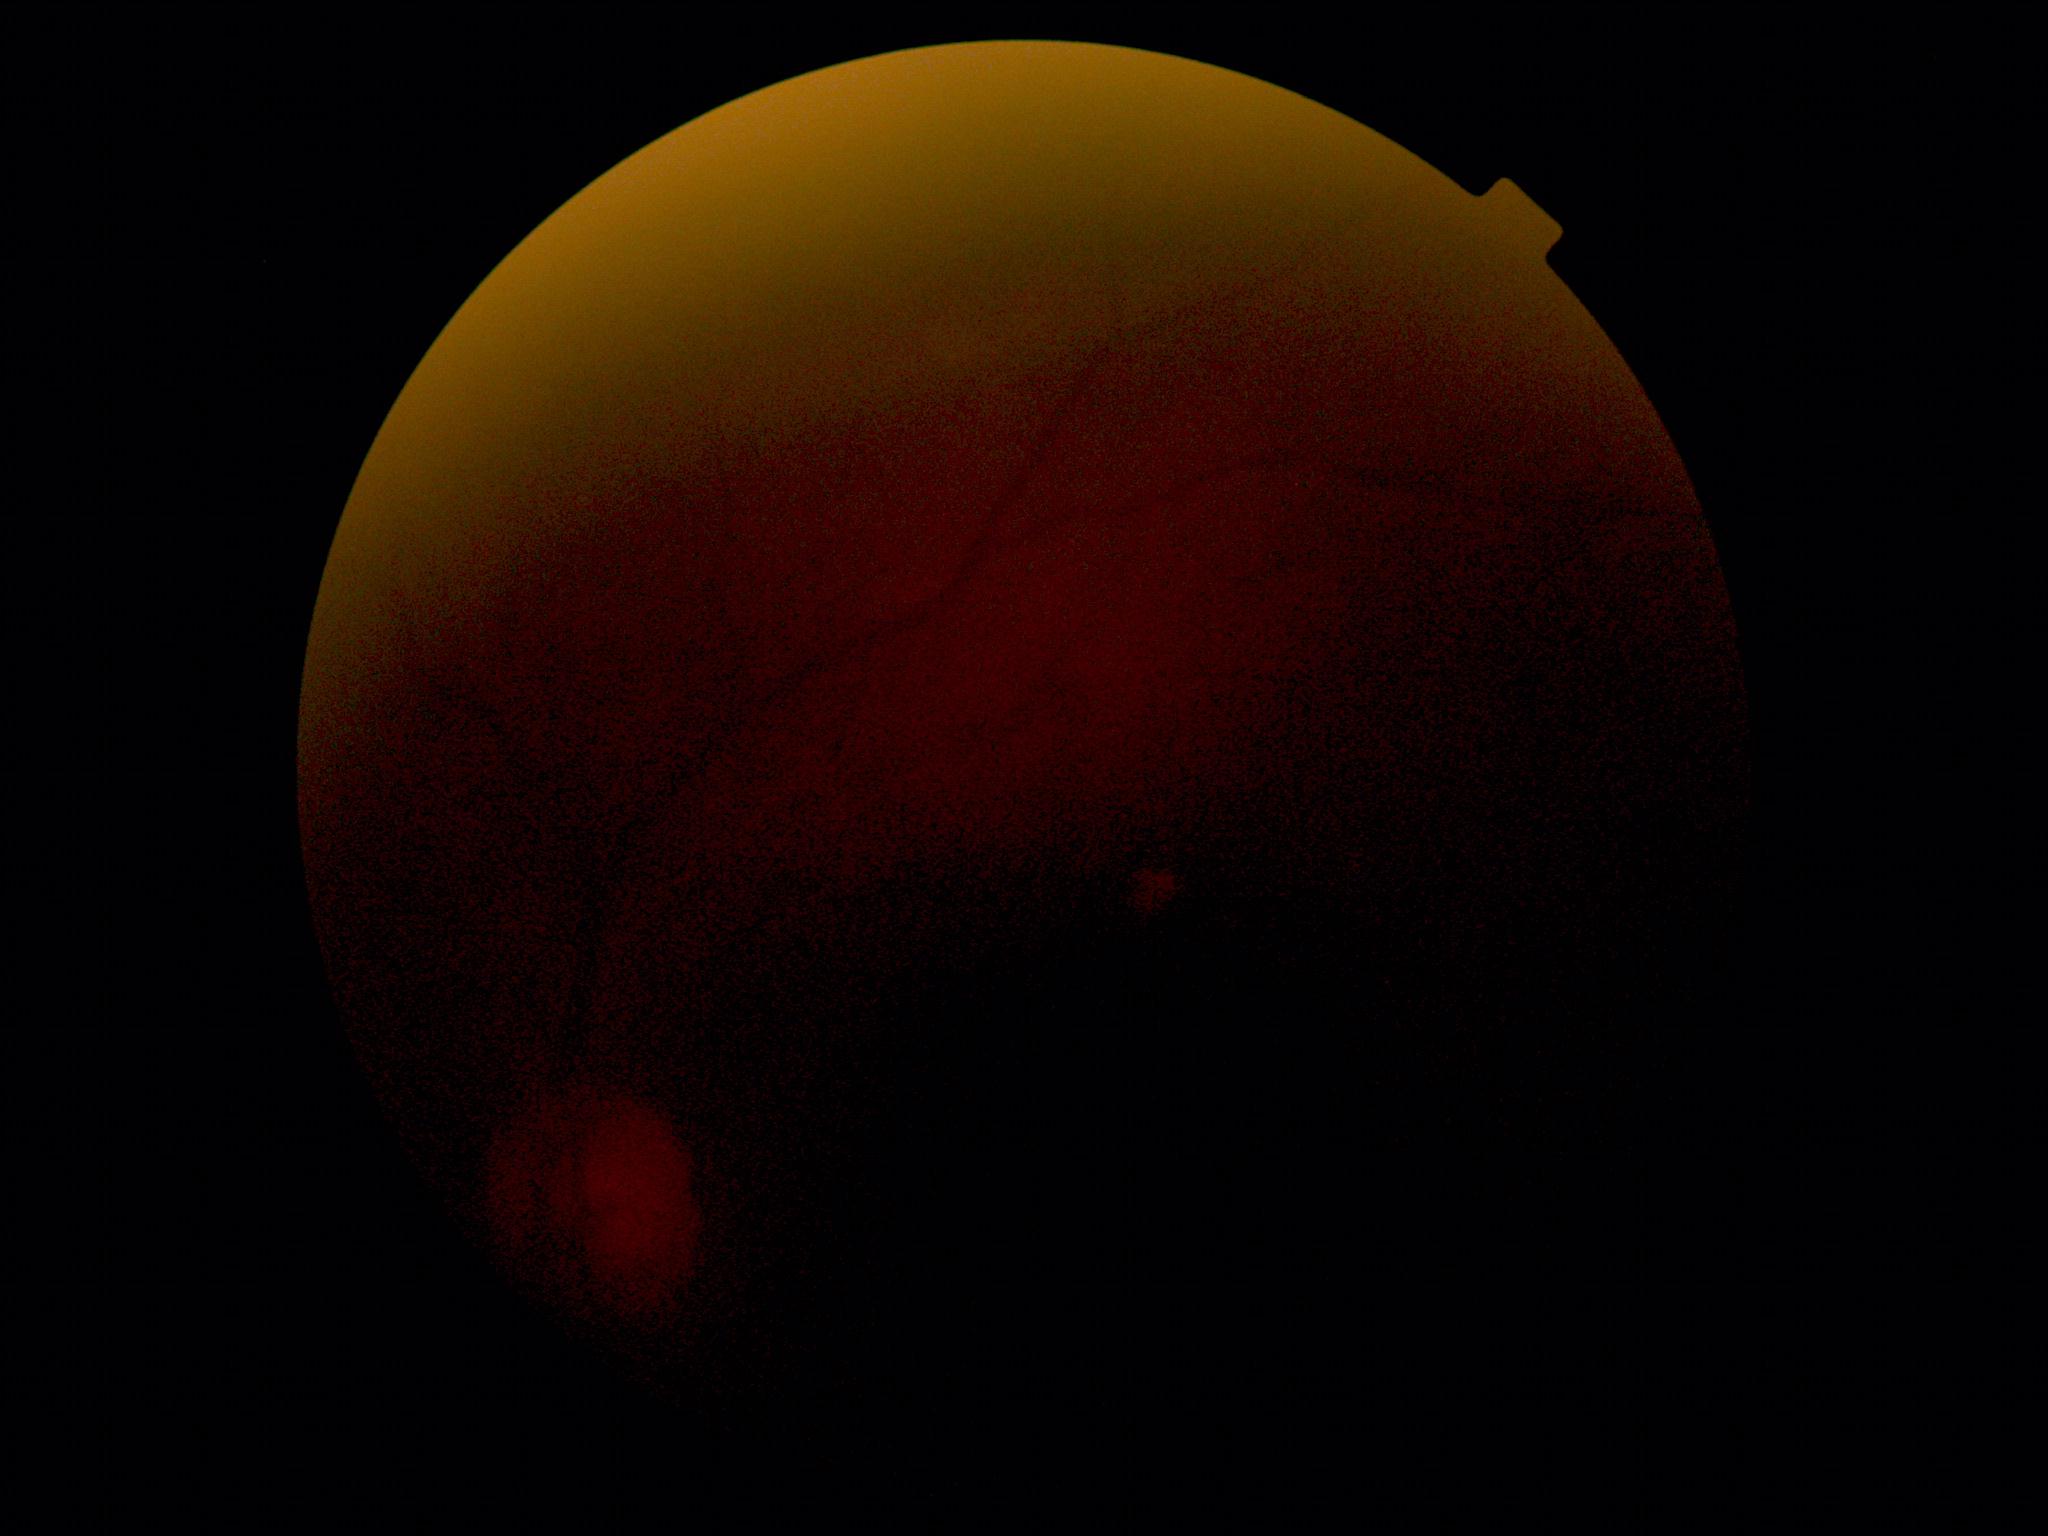

{"quality": "below grading threshold", "dr_grade": "ungradable"}